CFP; 1932x1932 — 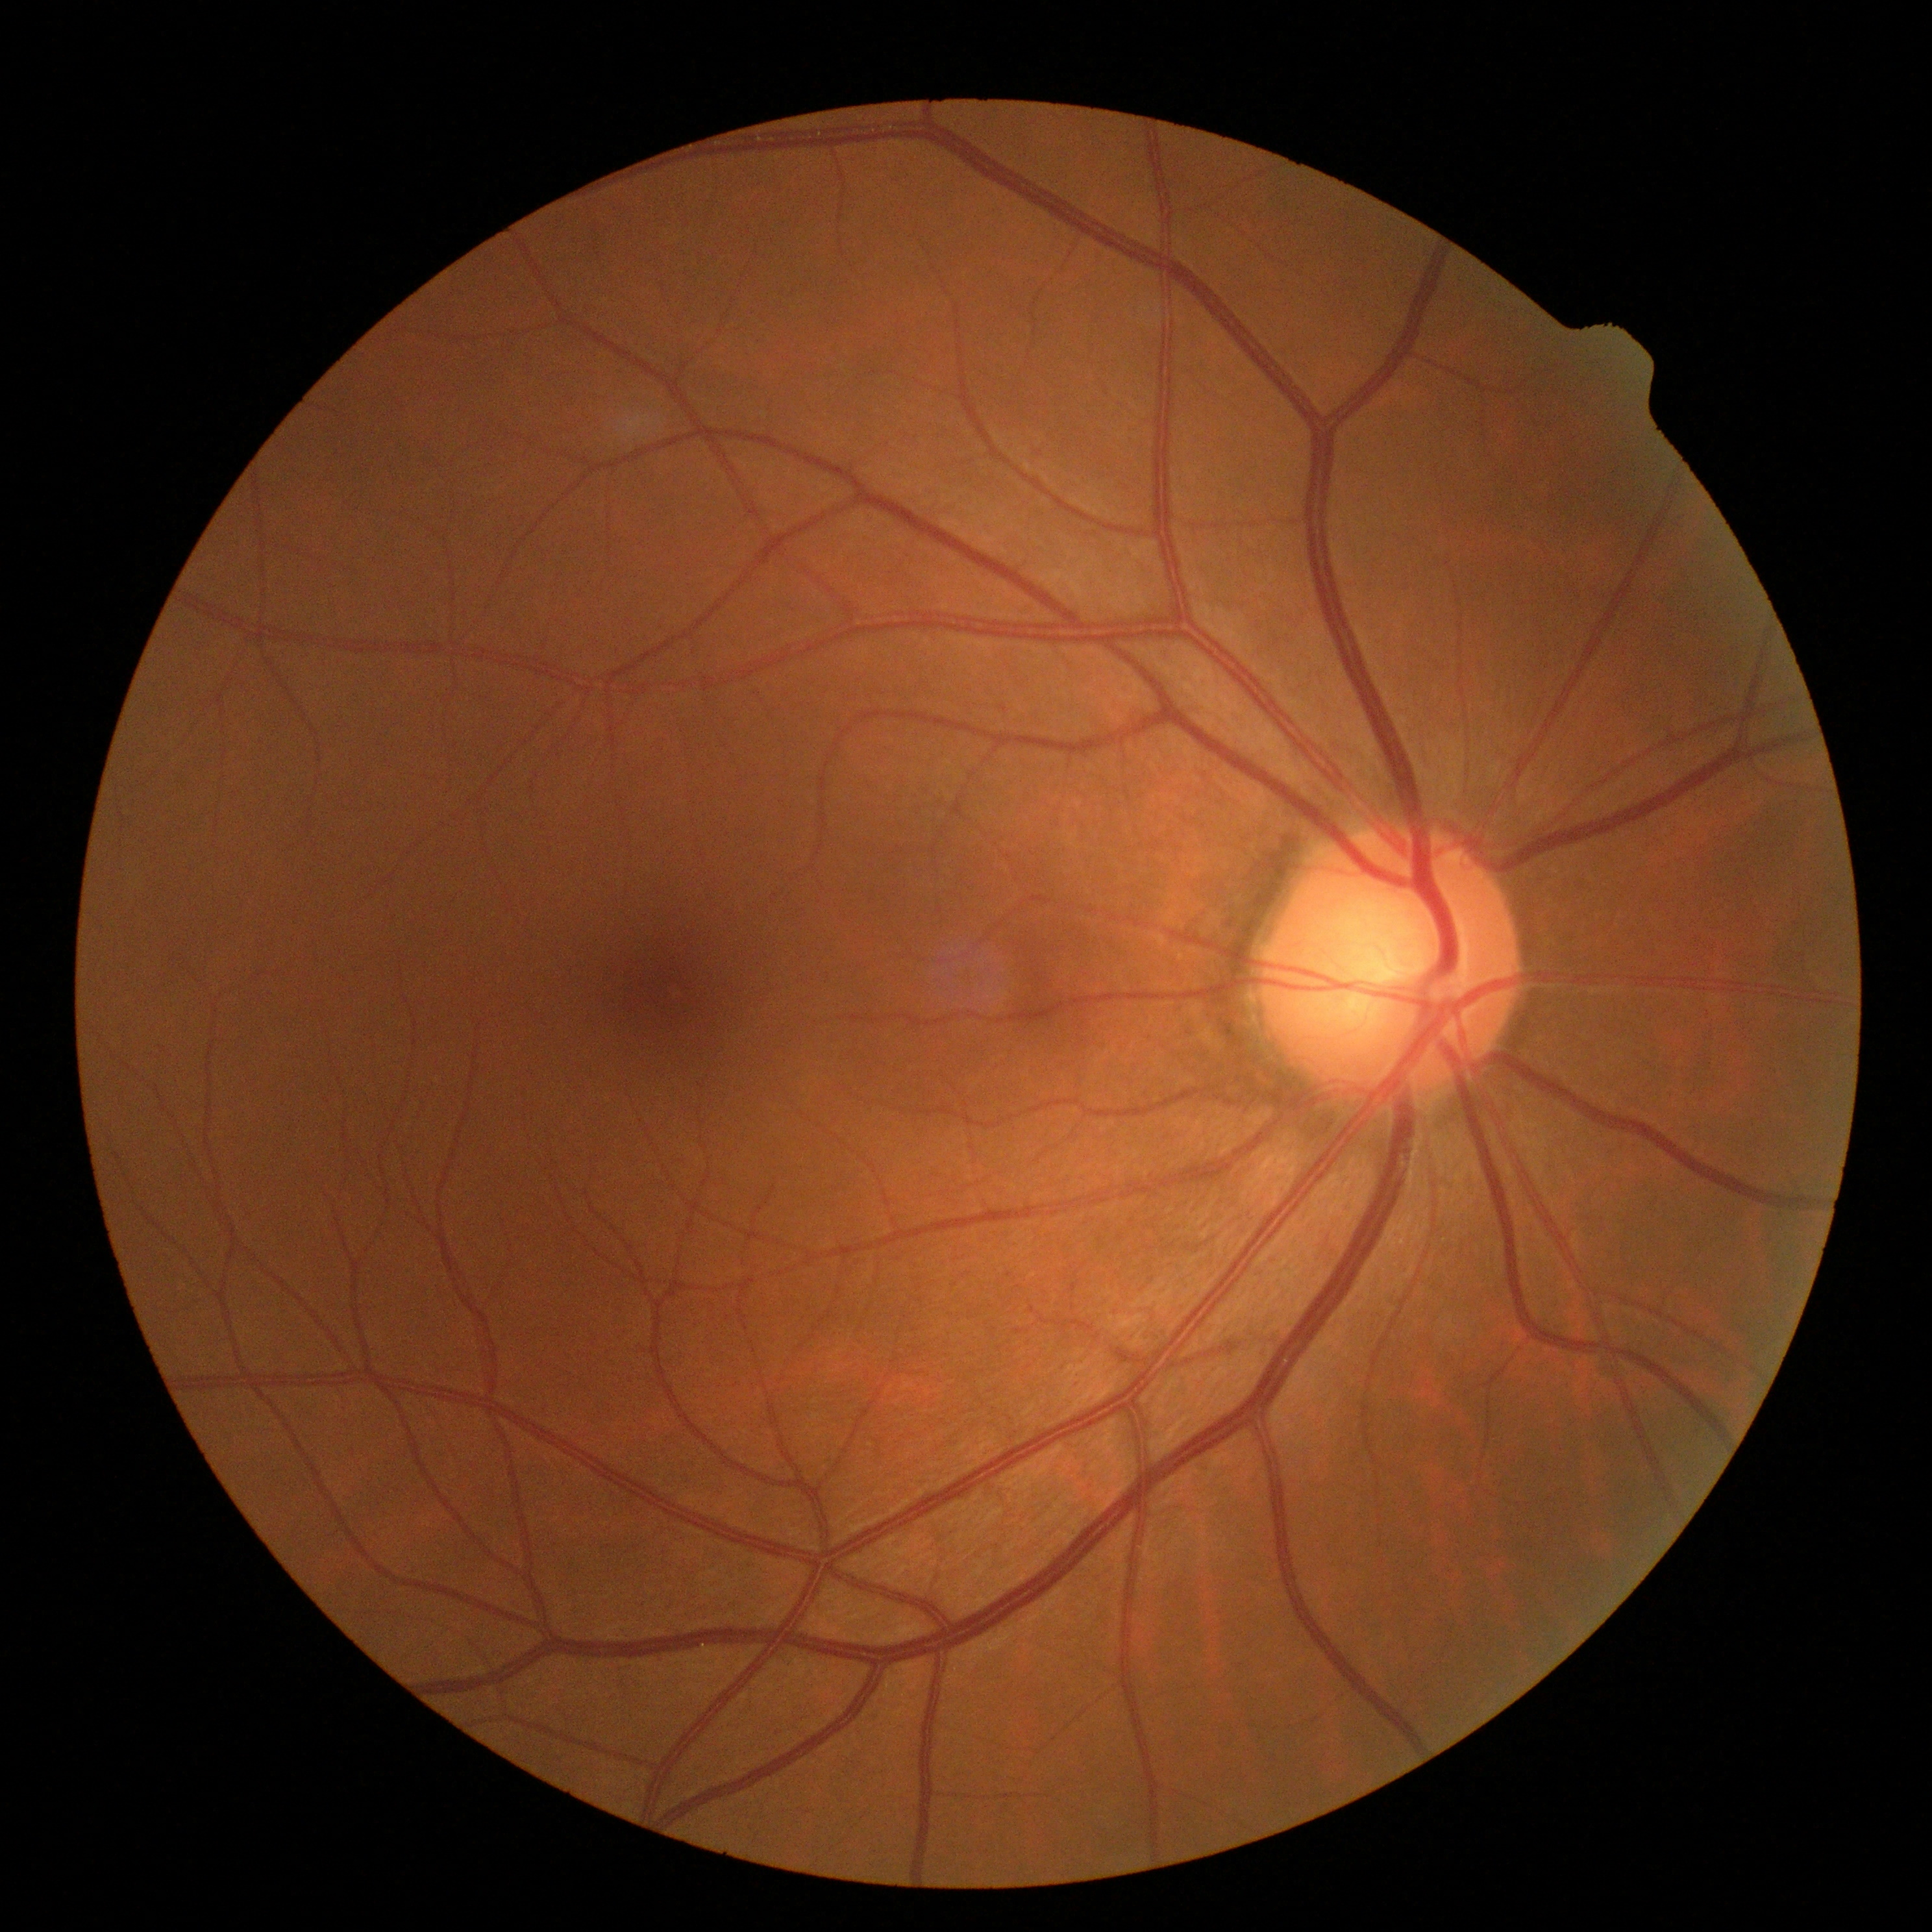
No apparent diabetic retinopathy. DR severity is grade 0.